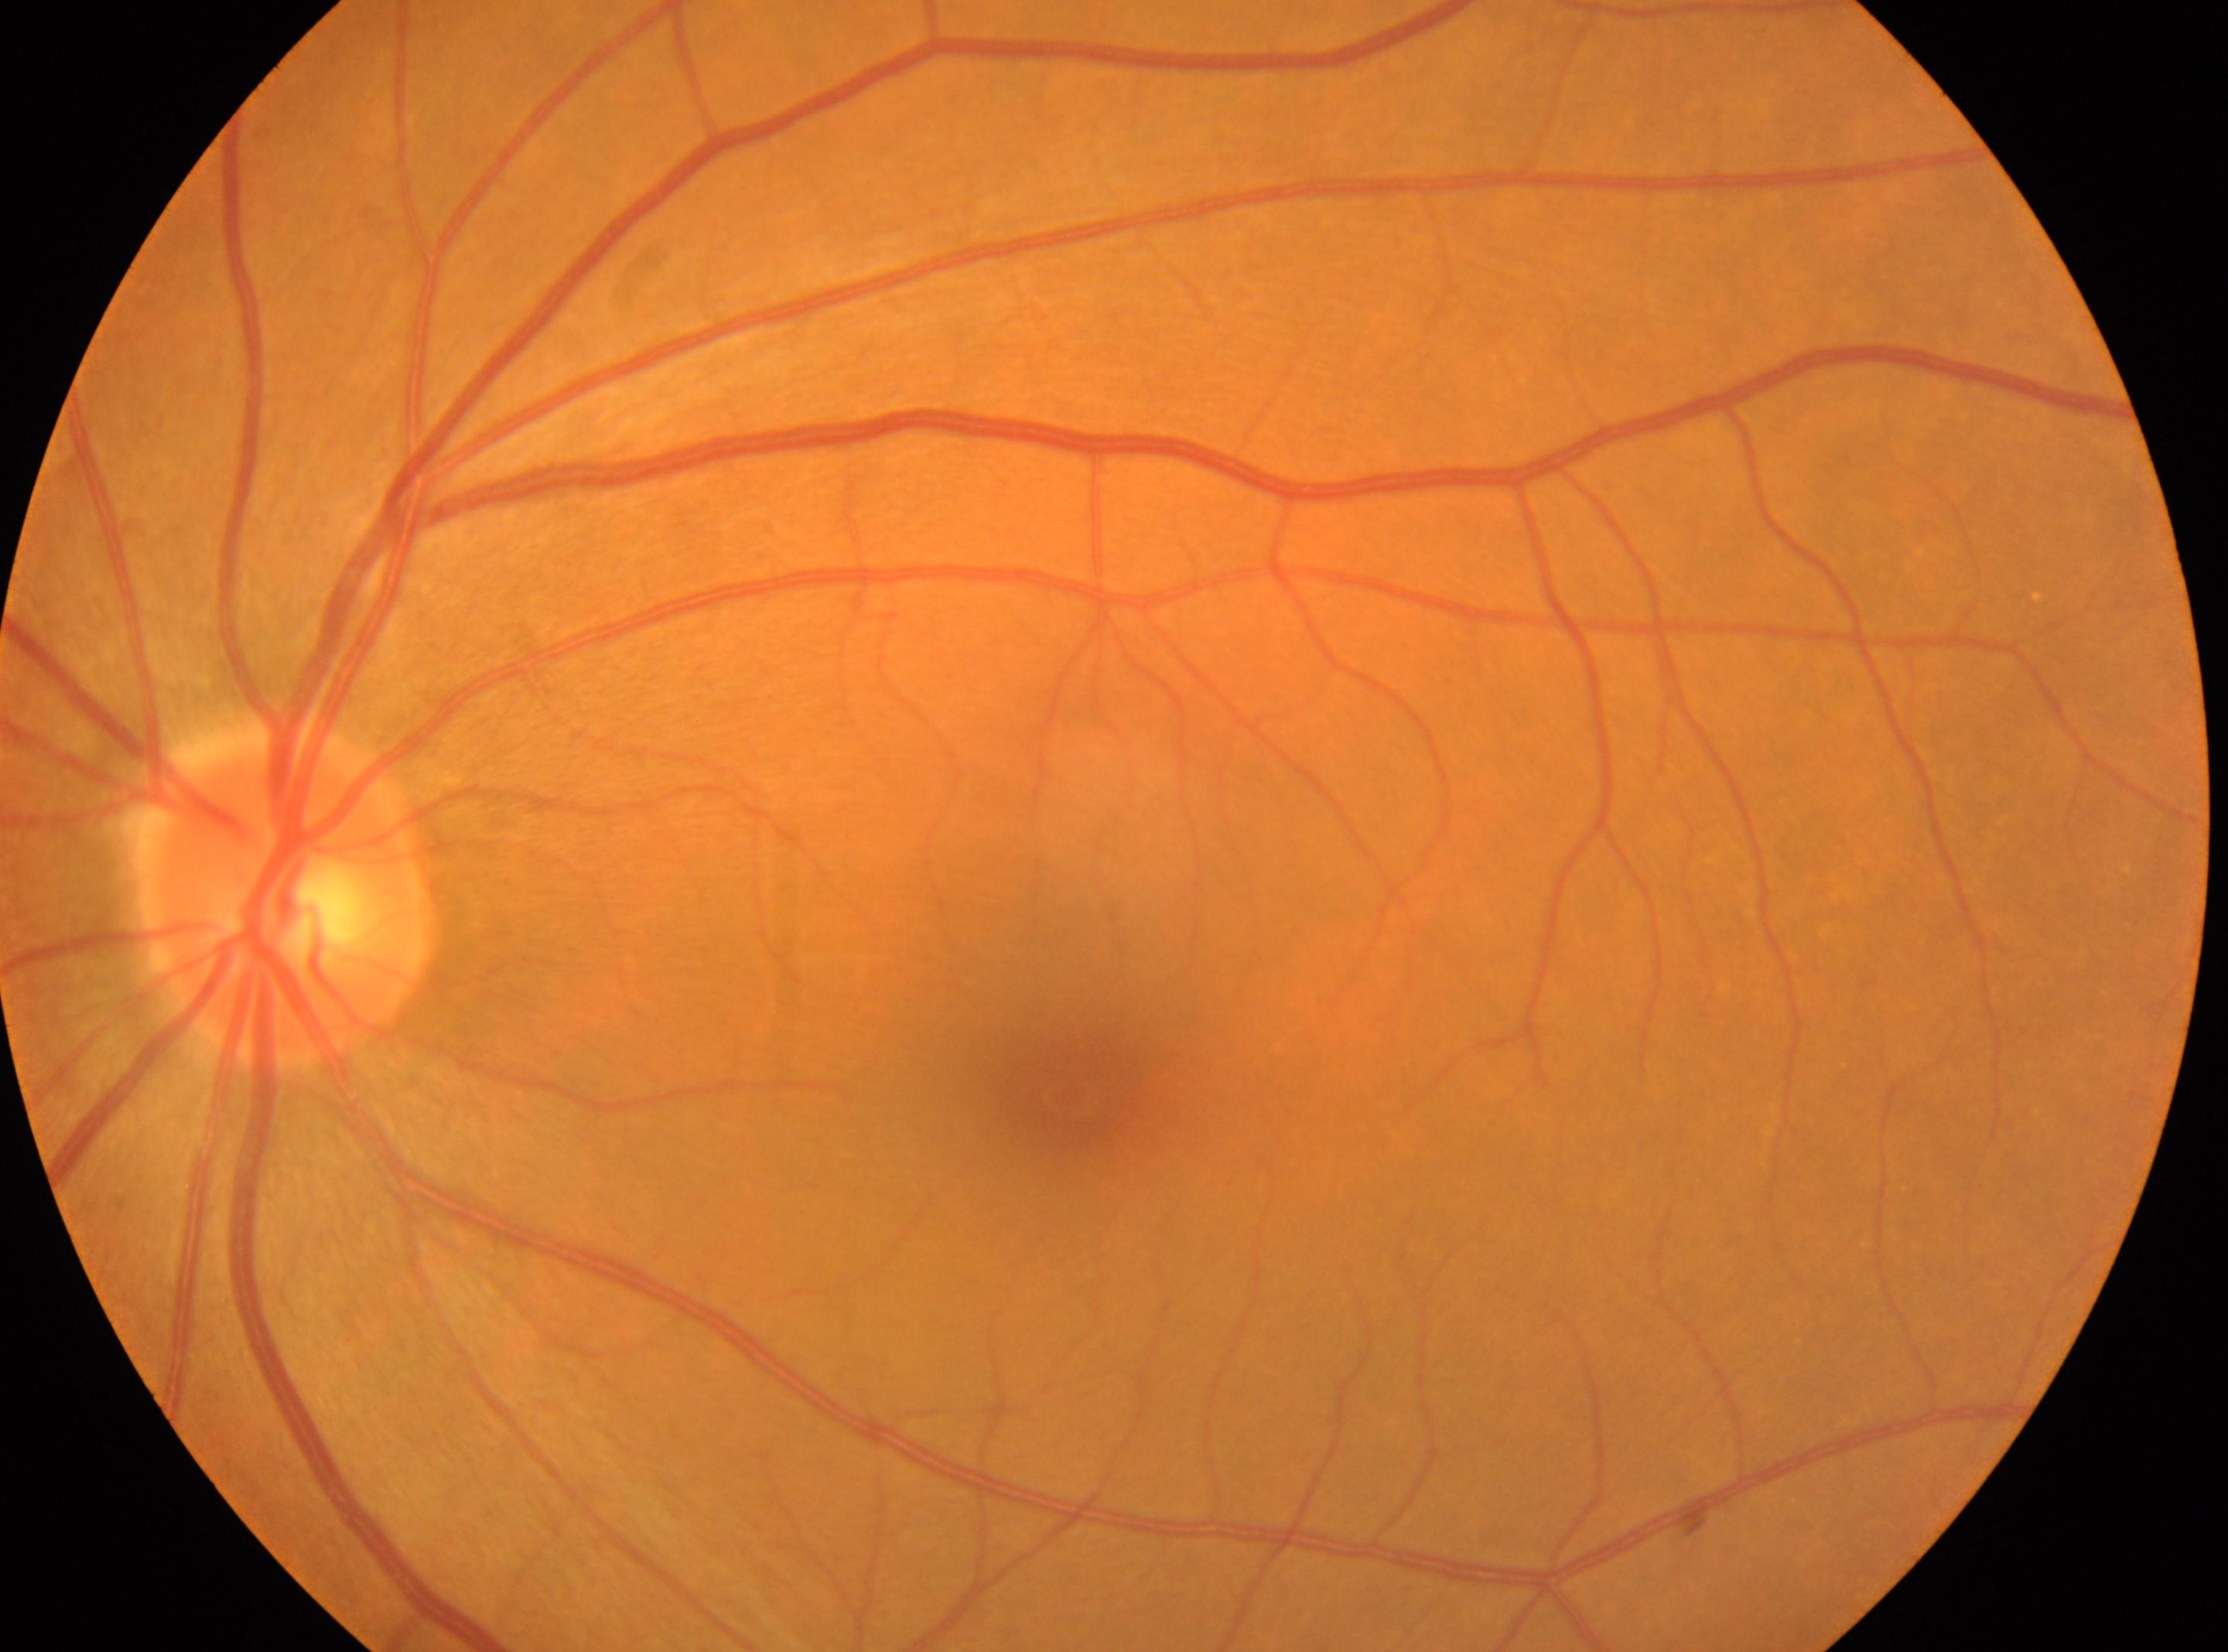
oculus sinister
fovea=1068, 1092
disc center=289, 894
DR stage=grade 0